2048x1536. 45° field of view — 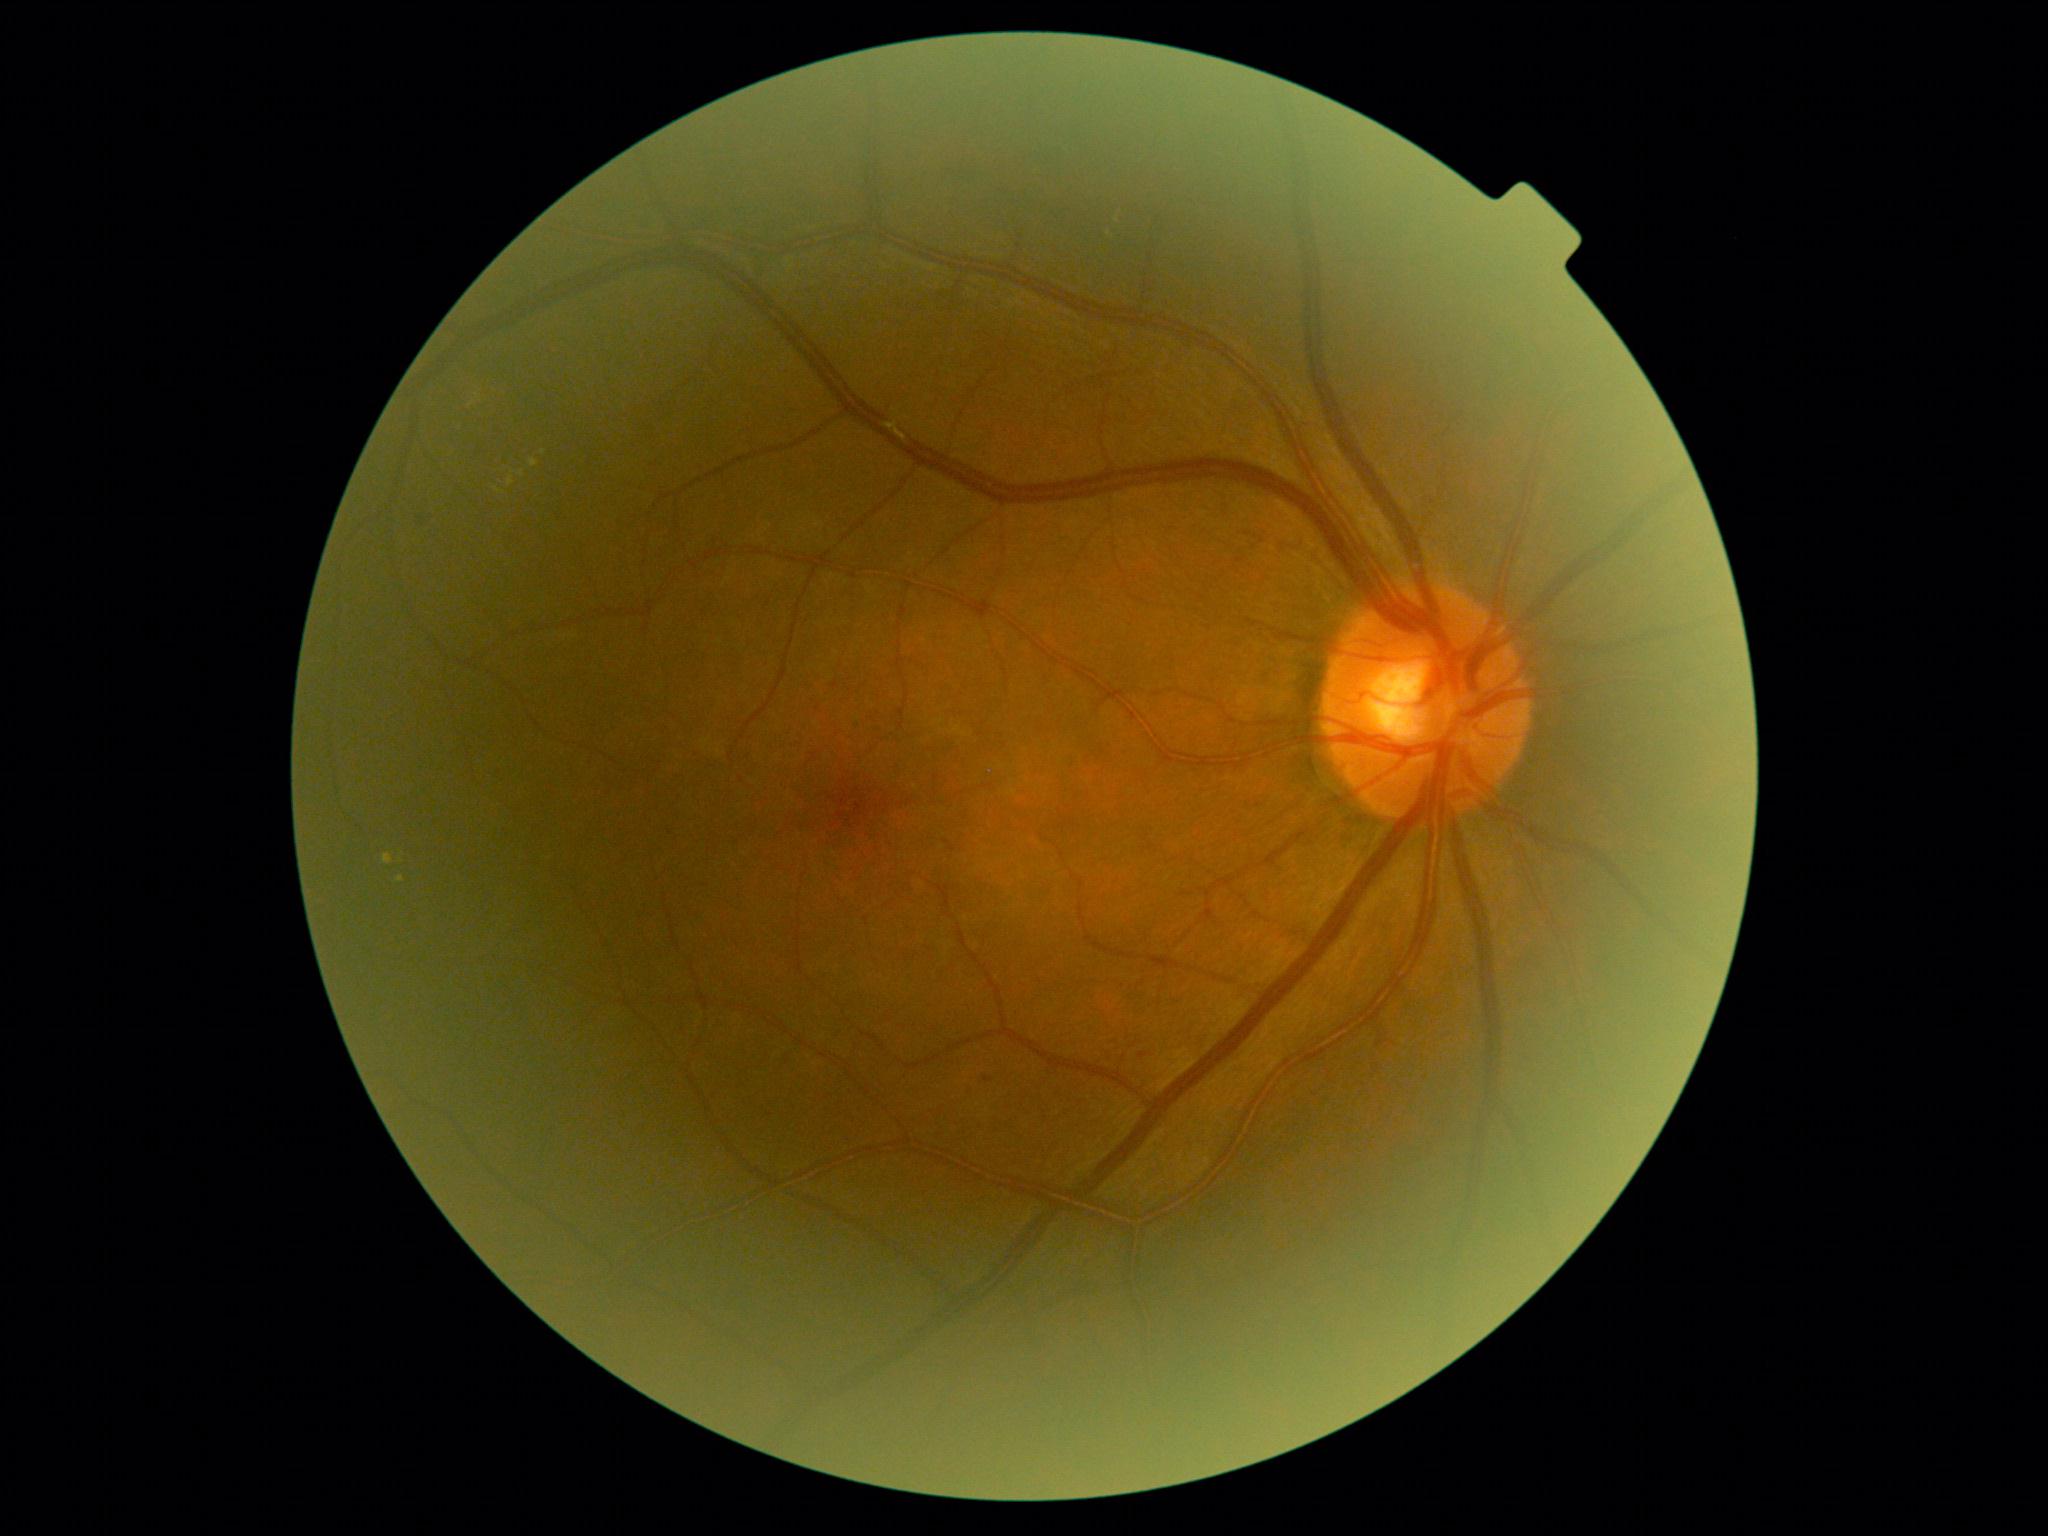

Retinopathy grade: 2 (moderate NPDR). DR class: non-proliferative diabetic retinopathy.